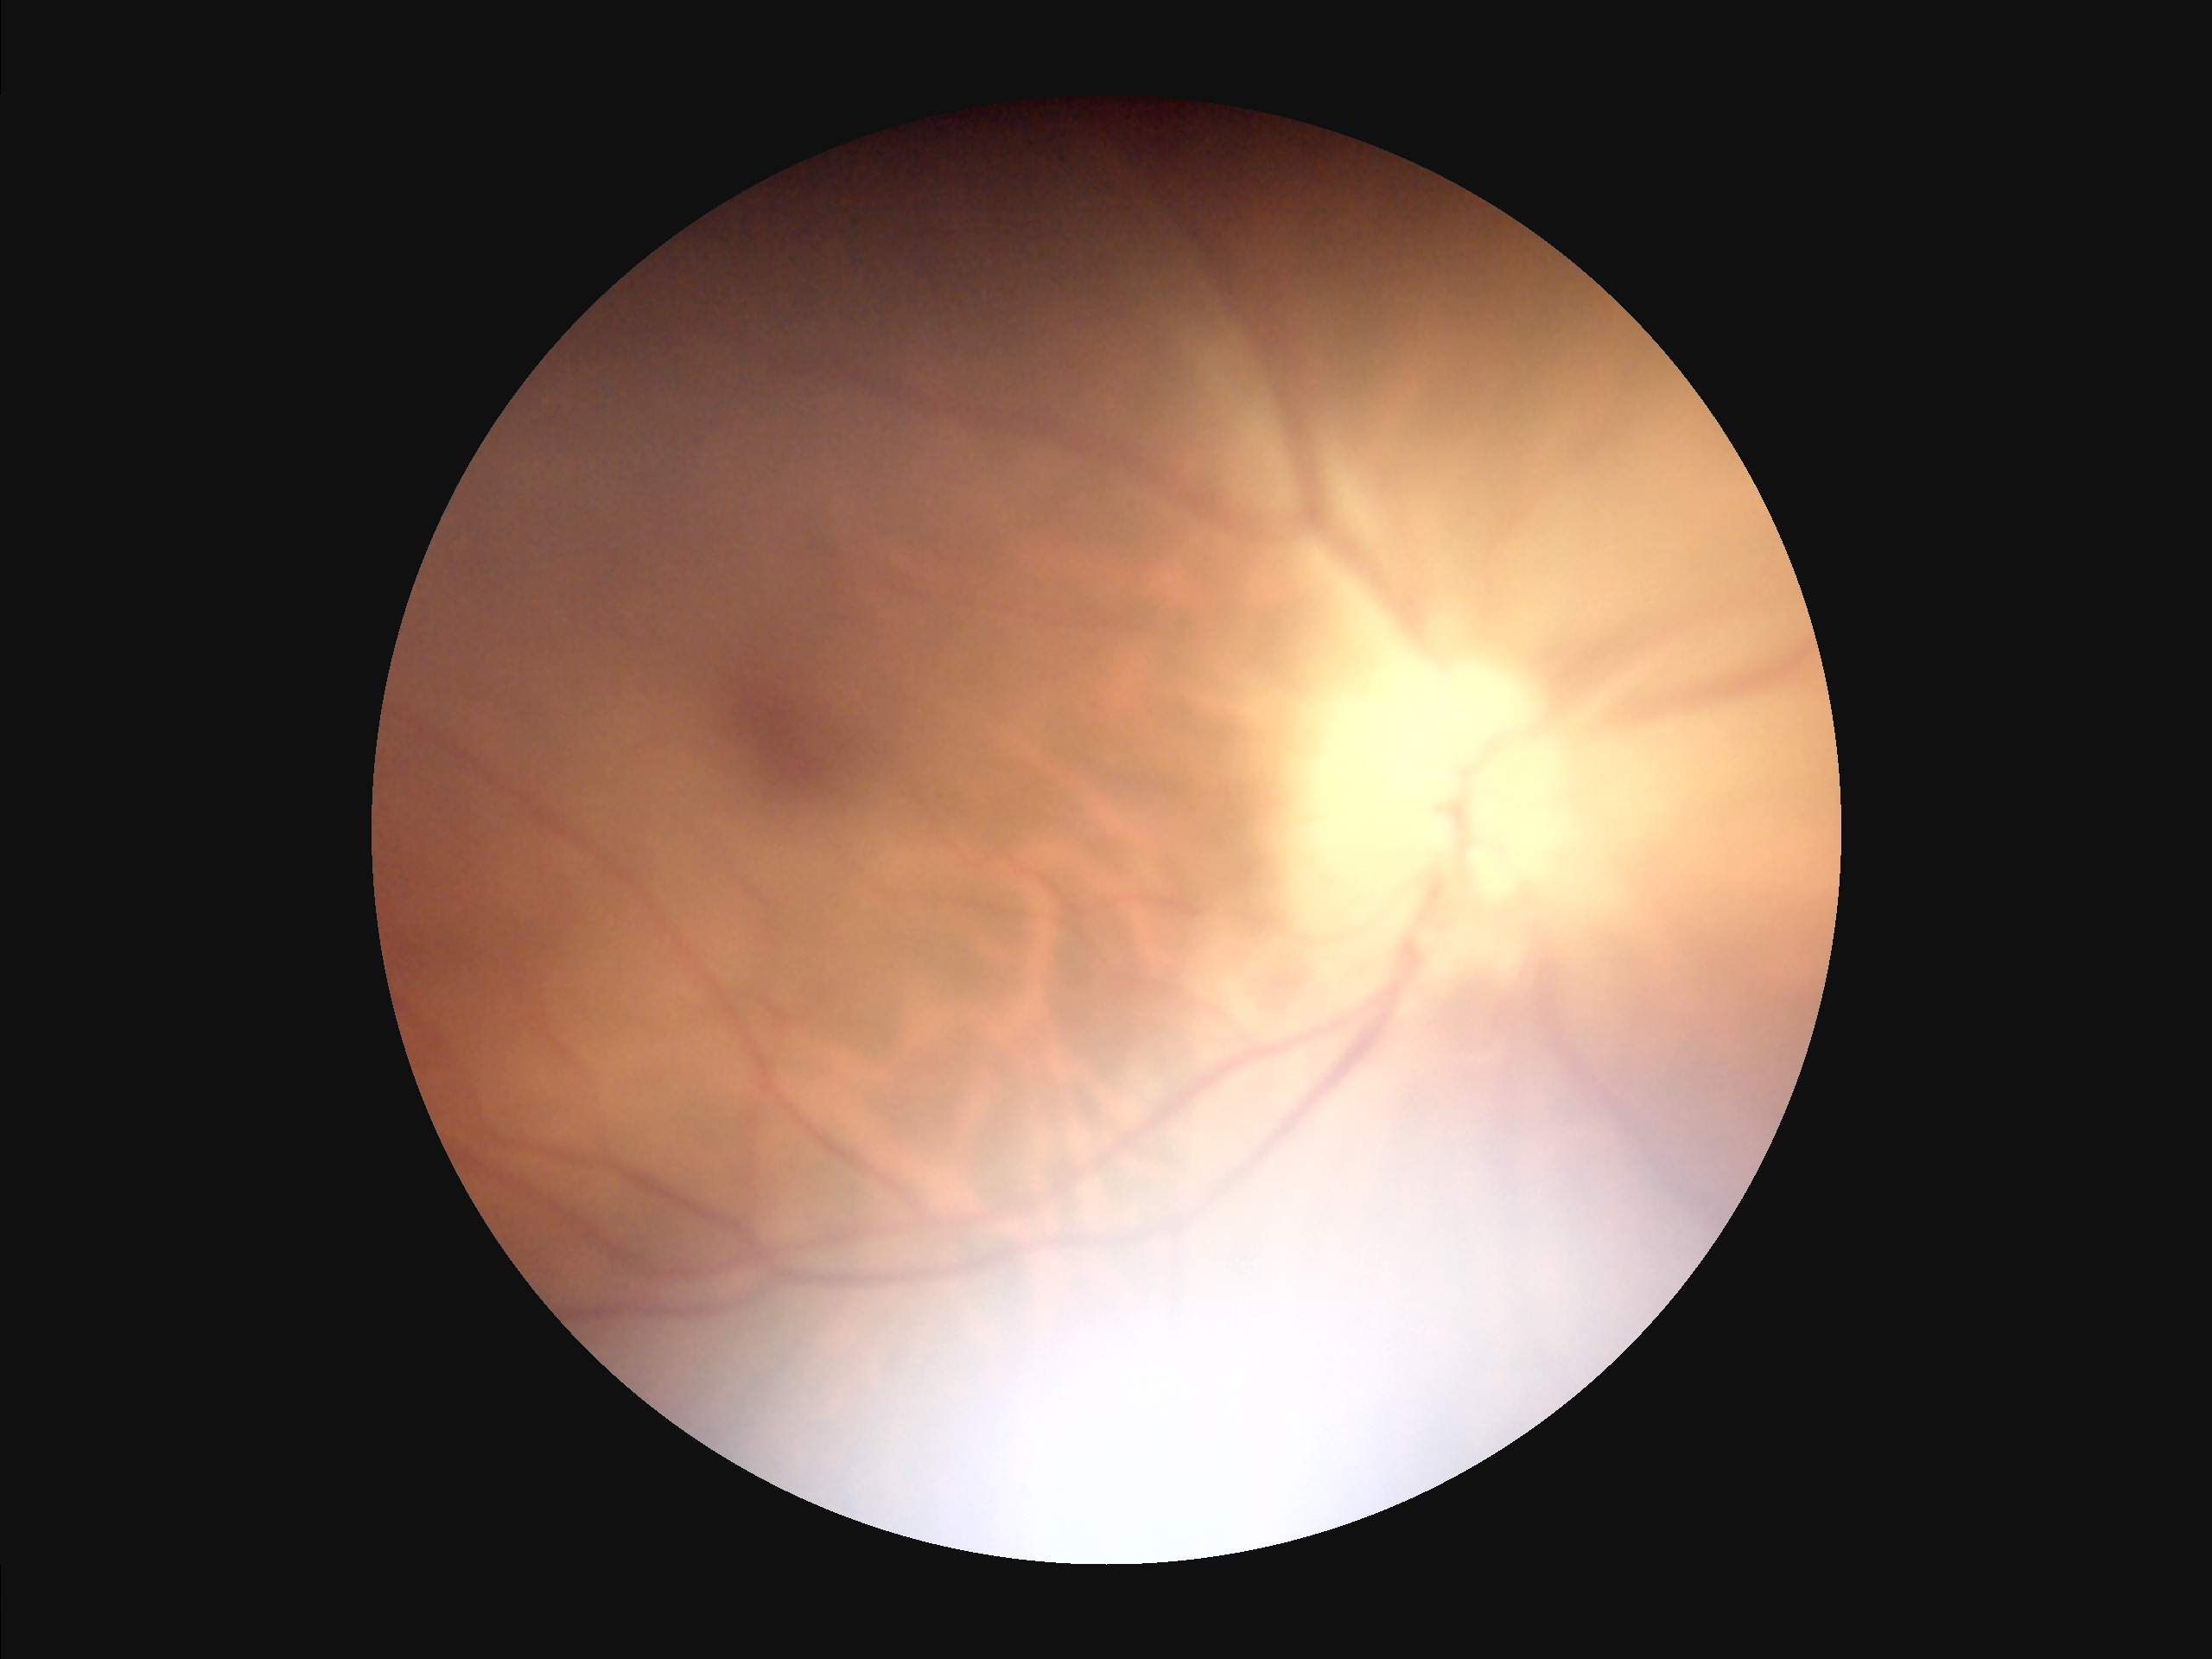

Overall quality is poor; the image is difficult to grade. Vessels and details are hard to distinguish. Out of focus; structures are indistinct. There is over- or under-exposure or a color cast.